2352 by 1568 pixels: 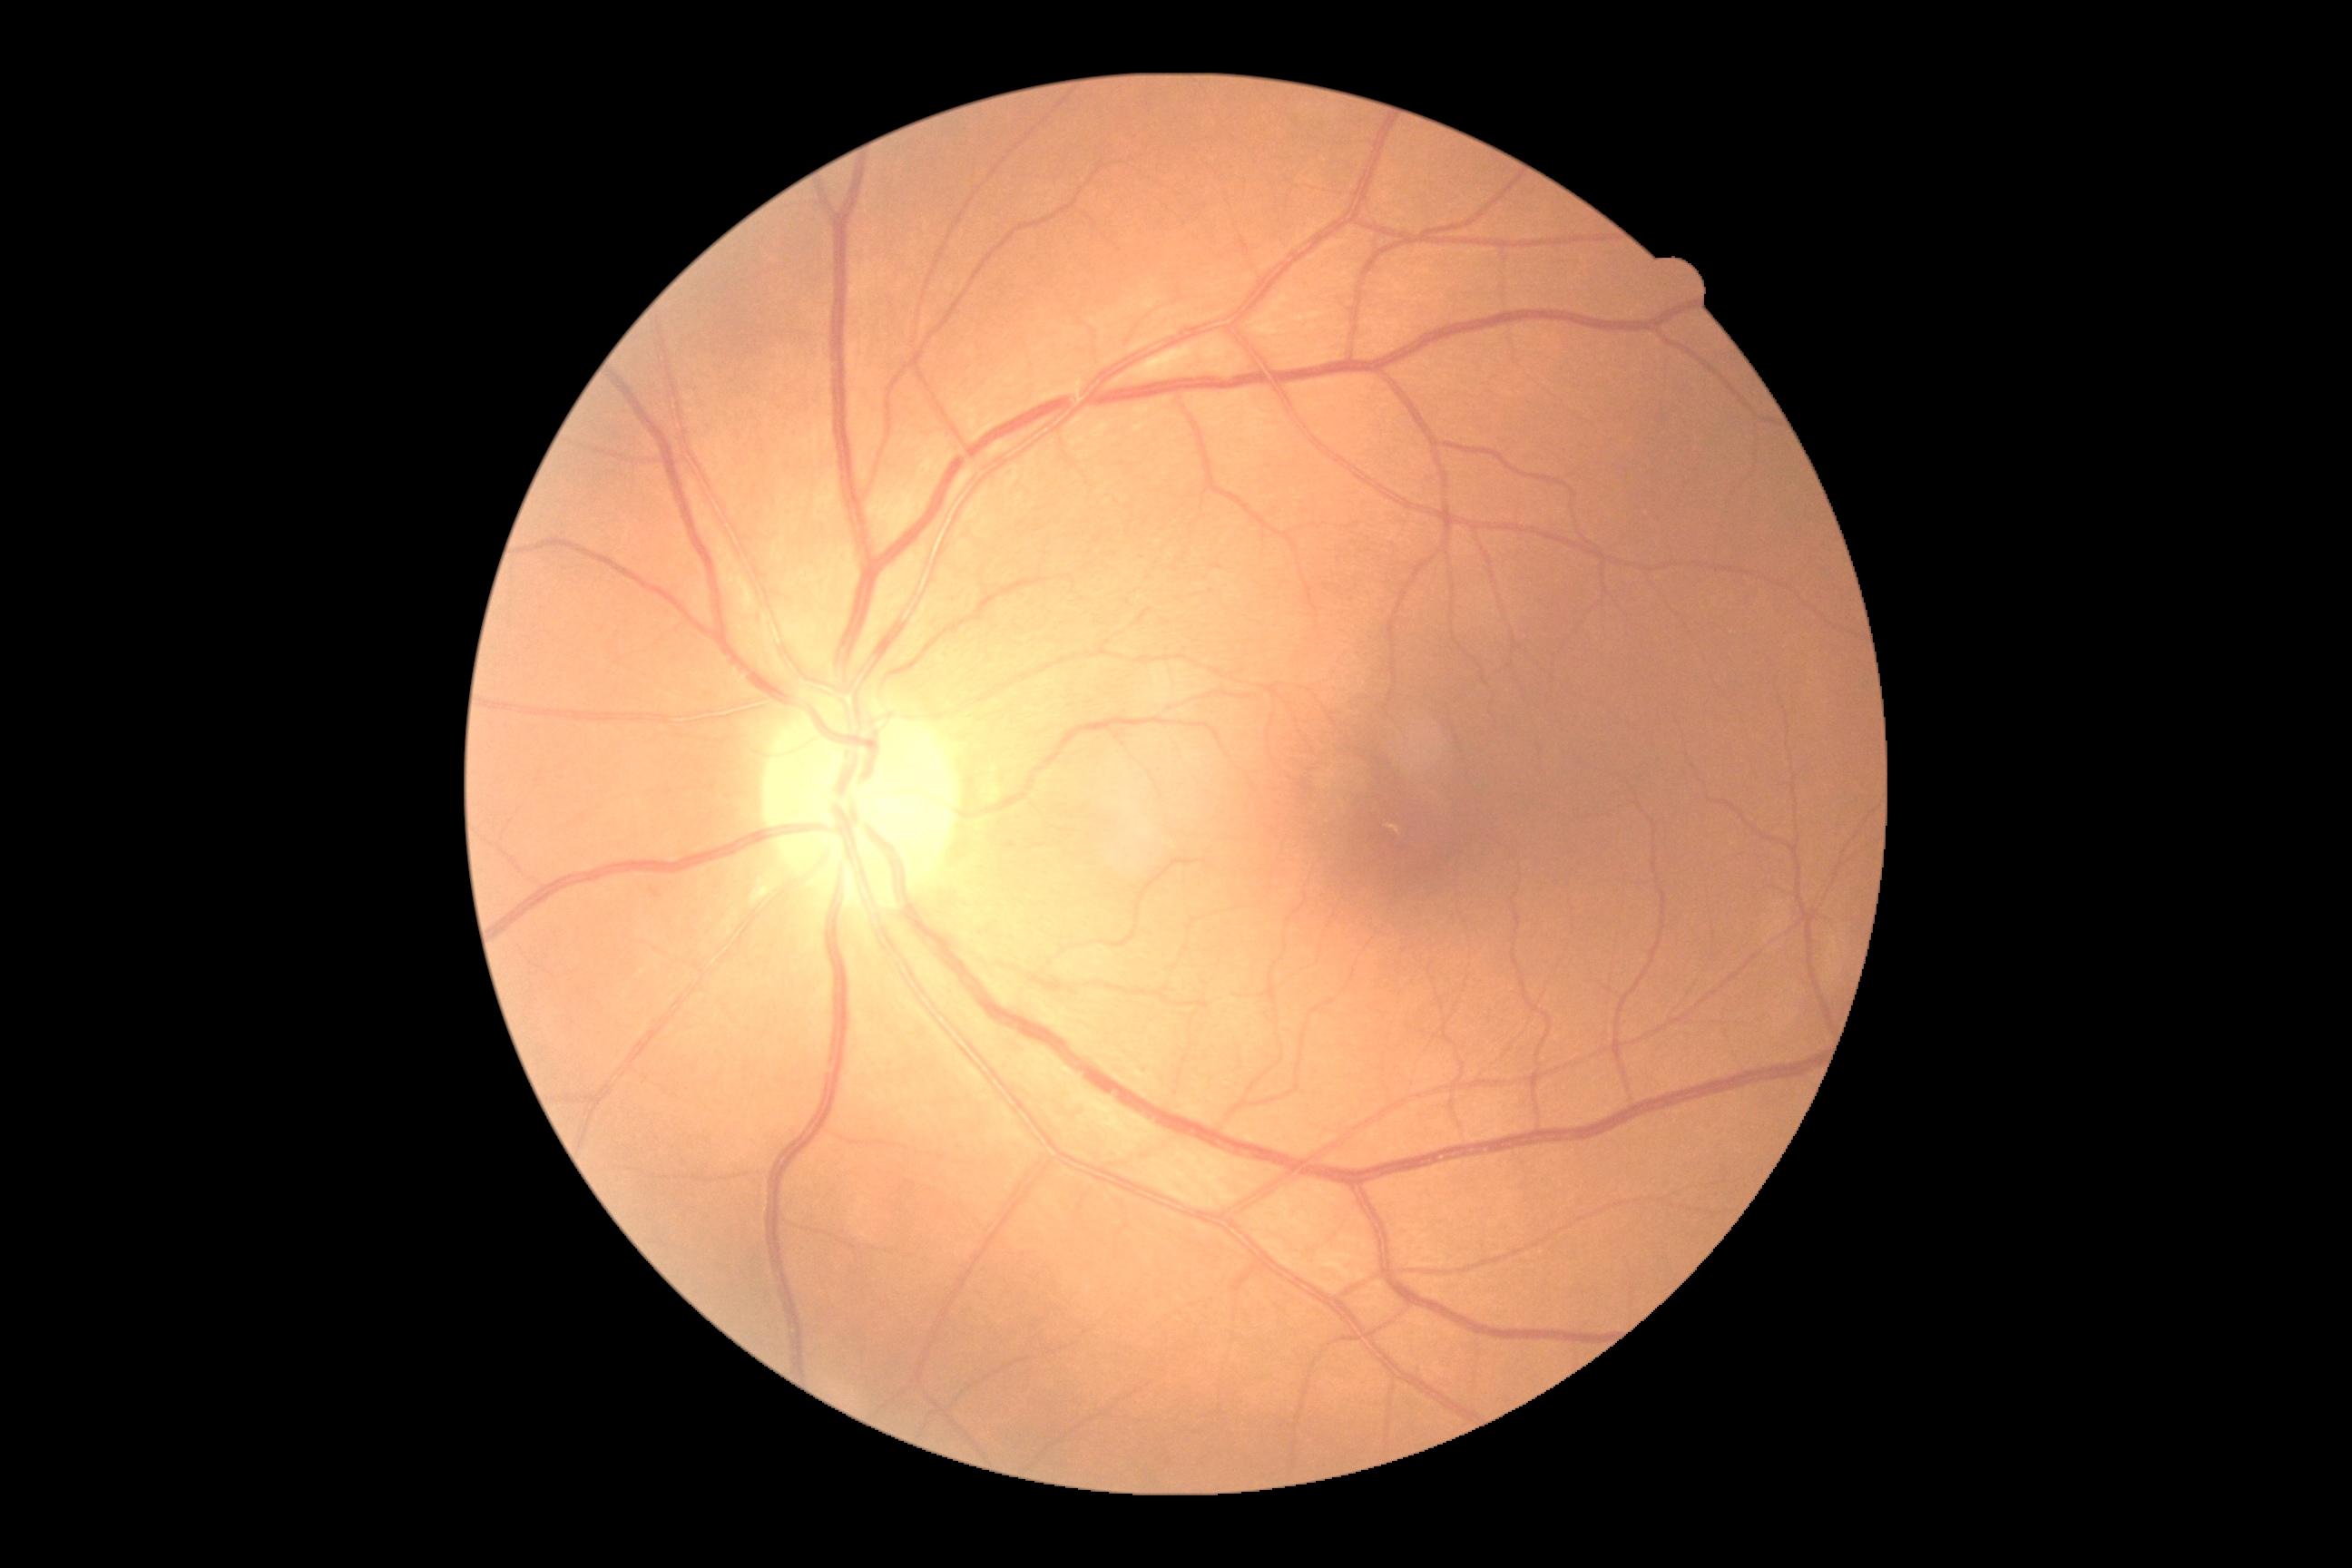
diabetic retinopathy (DR)=0/4.